240 by 240 pixels · captured without pupil dilation · fundus photo — 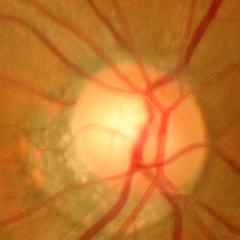

Q: What stage of glaucoma is present?
A: No glaucoma.